Color fundus image. Graded on the modified Davis scale. NIDEK AFC-230 fundus camera: 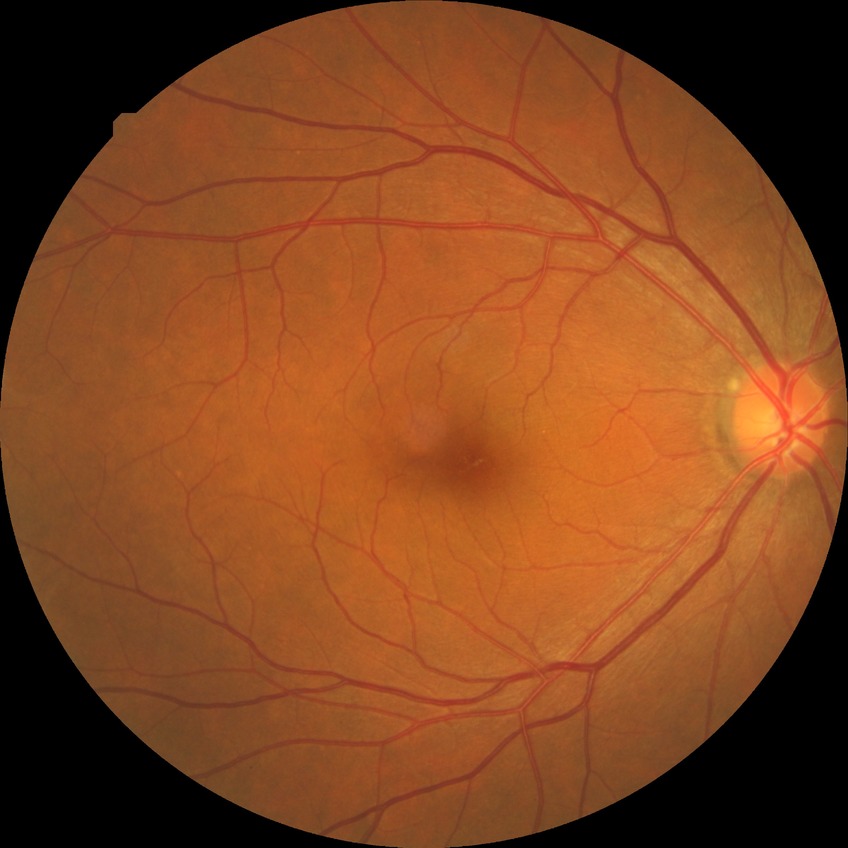
Annotations:
• modified Davis classification — no diabetic retinopathy